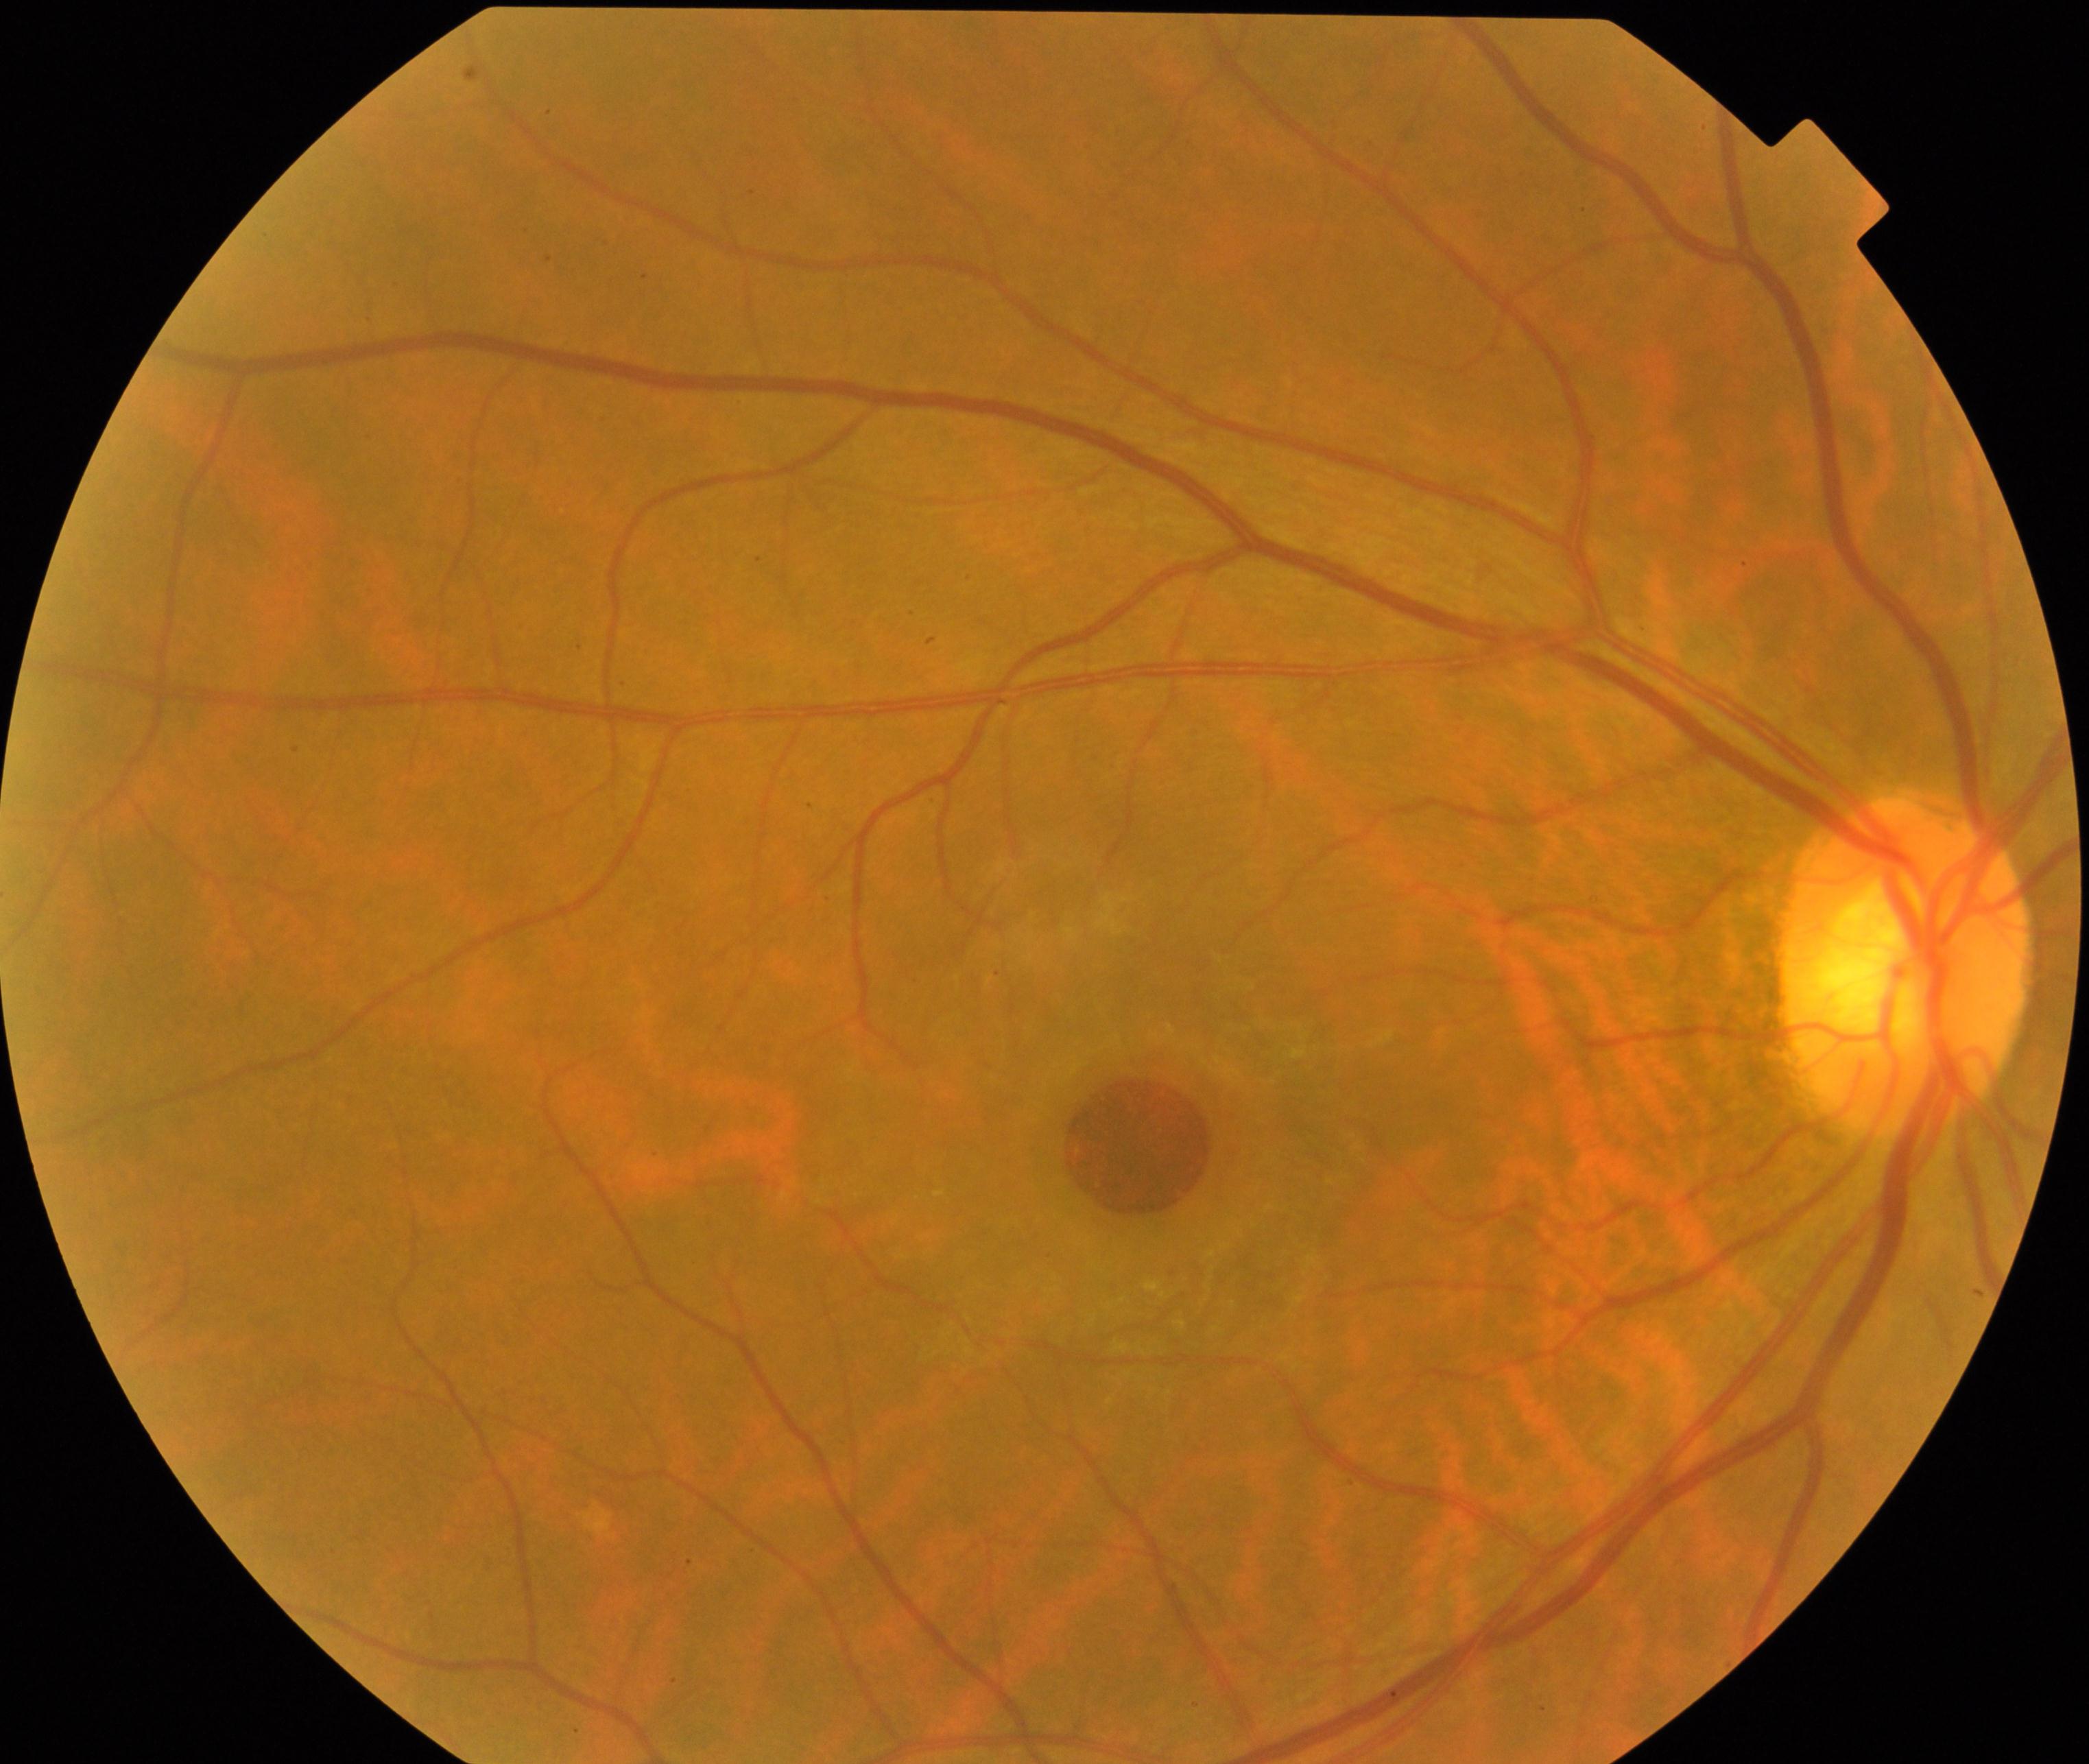

Demonstrates MH (macular hole). Characterized by central foveal defect, round or oval, sometimes with multiple yellow deposits within the crater or a surrounding cuff of subretinal fluid.